Infant wide-field fundus photograph.
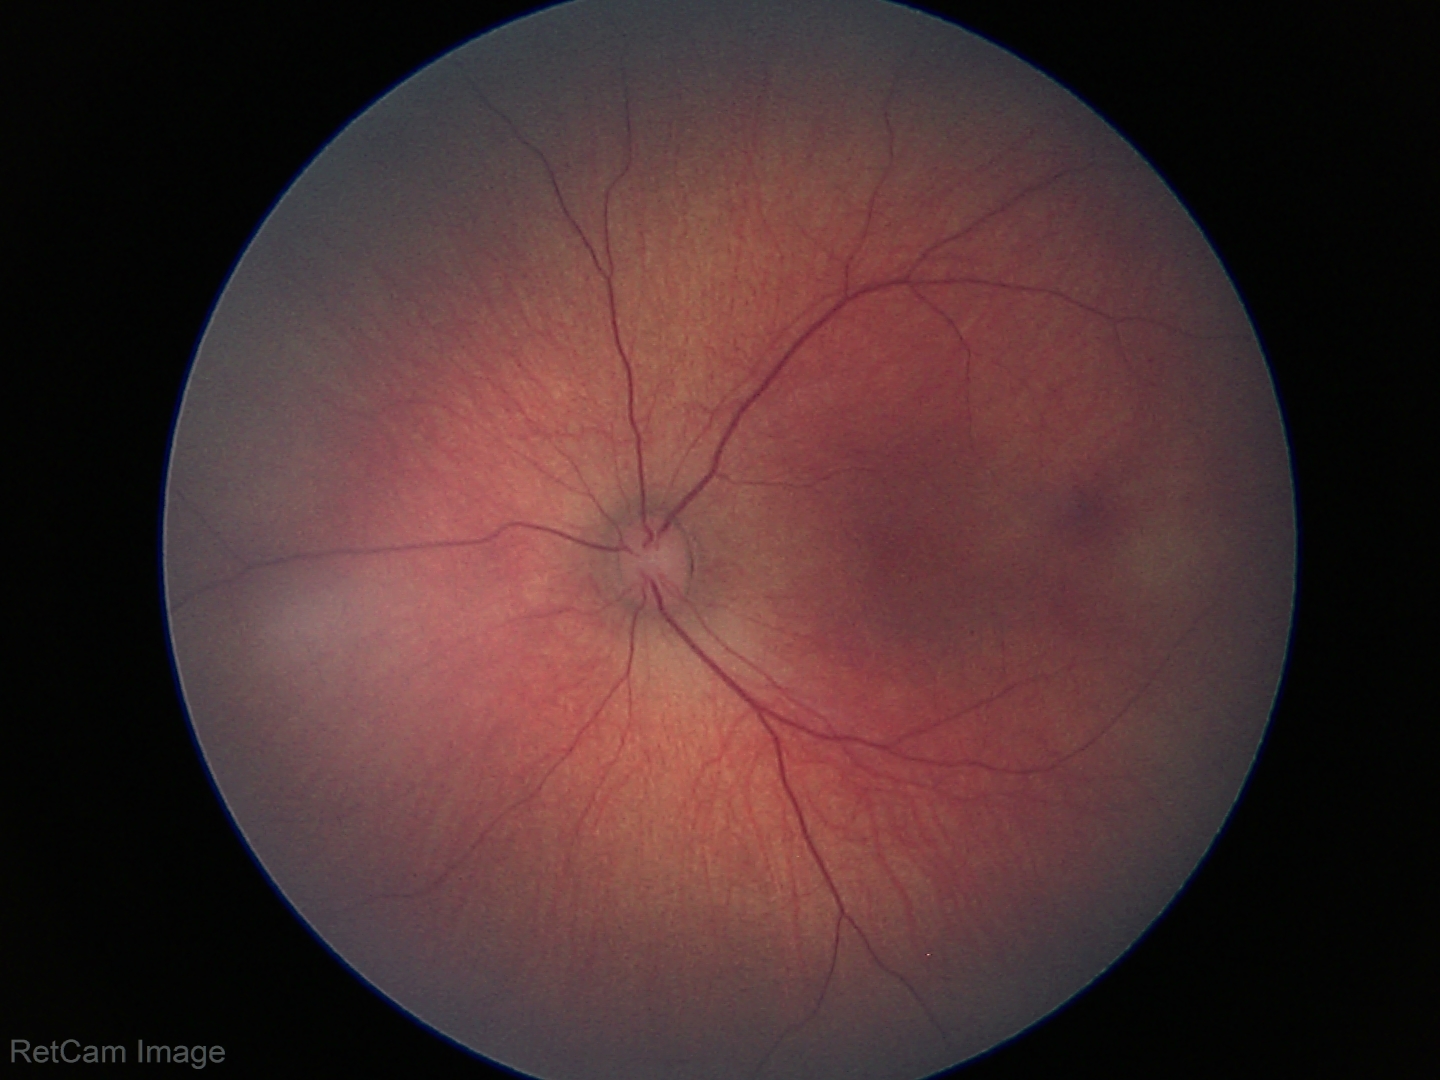

Examination with physiological retinal findings.